Modified Davis classification — 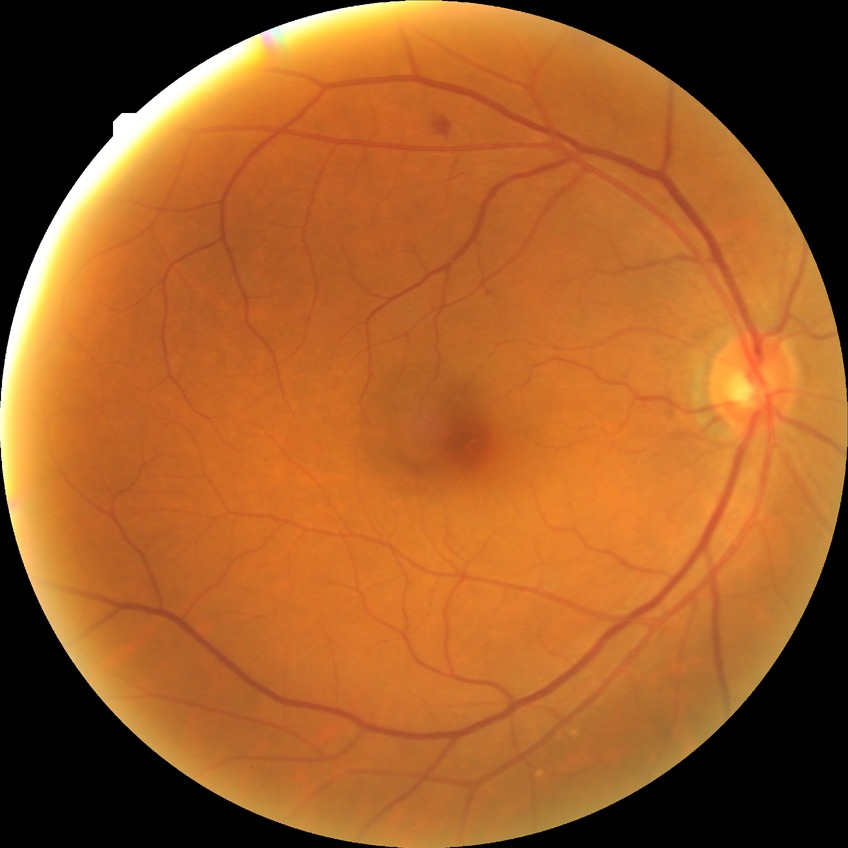
Diabetic retinopathy (DR): SDR (simple diabetic retinopathy).